DR severity per modified Davis staging.
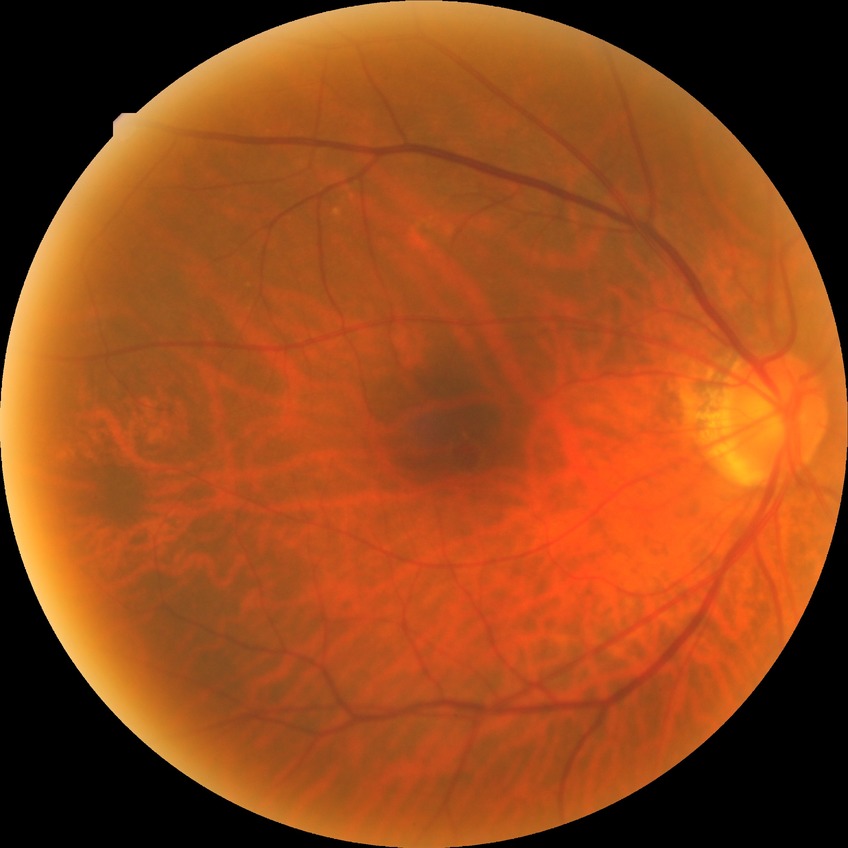 Davis grading is no diabetic retinopathy.